Wide-field fundus photograph of an infant · camera: Phoenix ICON (100° FOV) · 1240 by 1240 pixels.
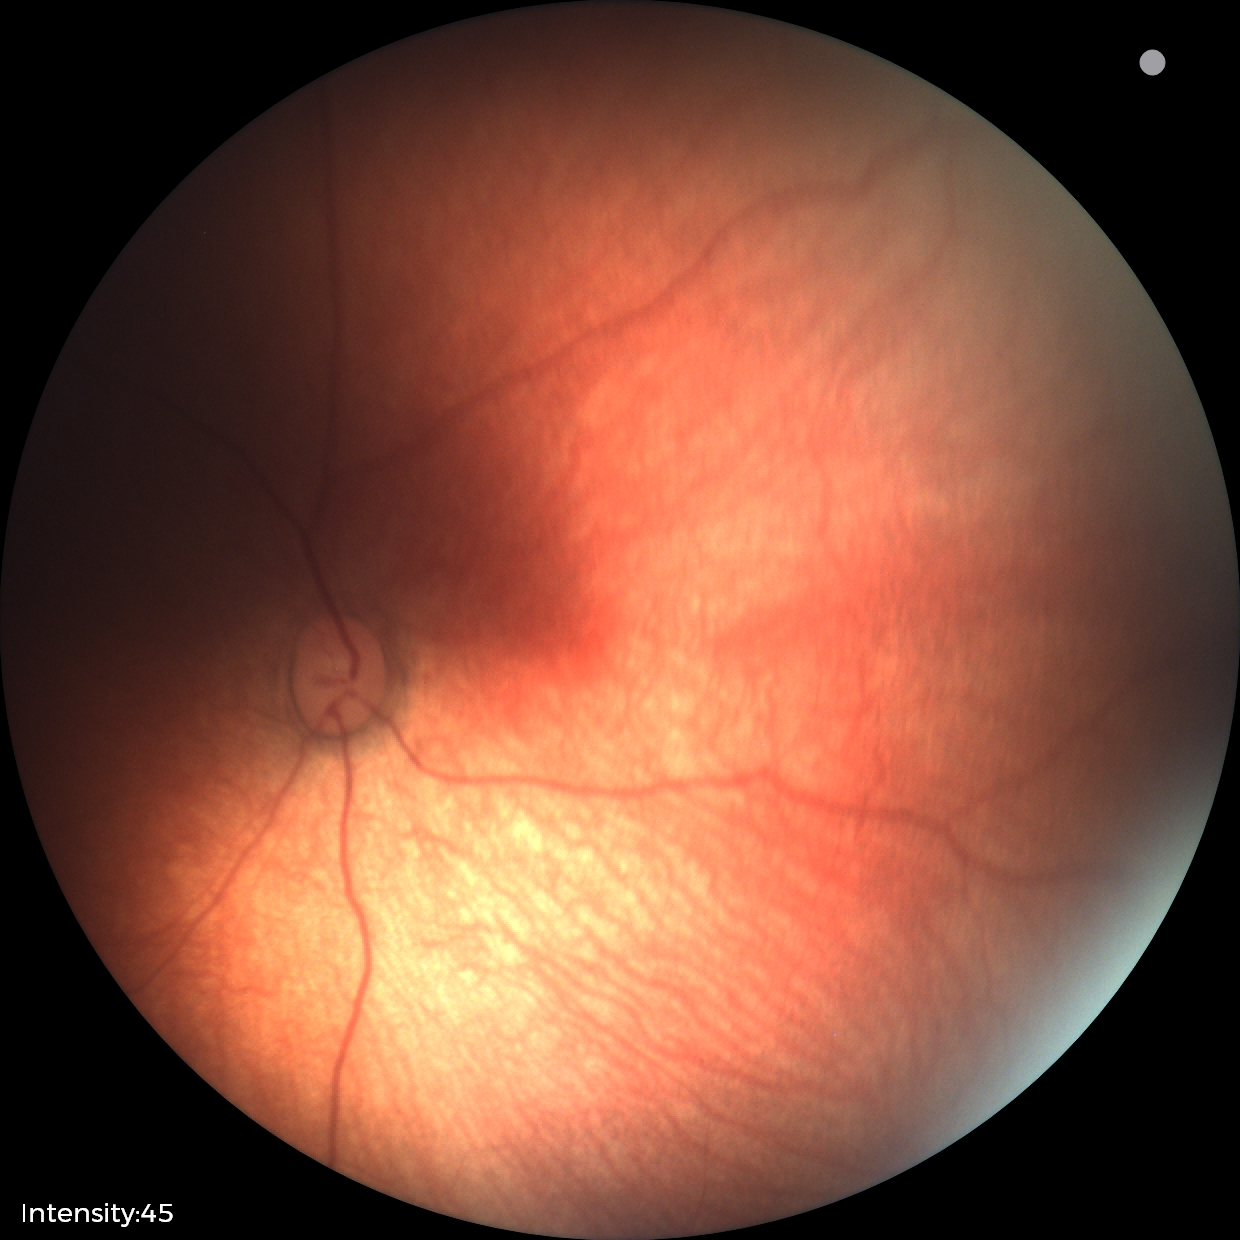
Screening examination with no abnormal retinal findings.